Without pupil dilation:
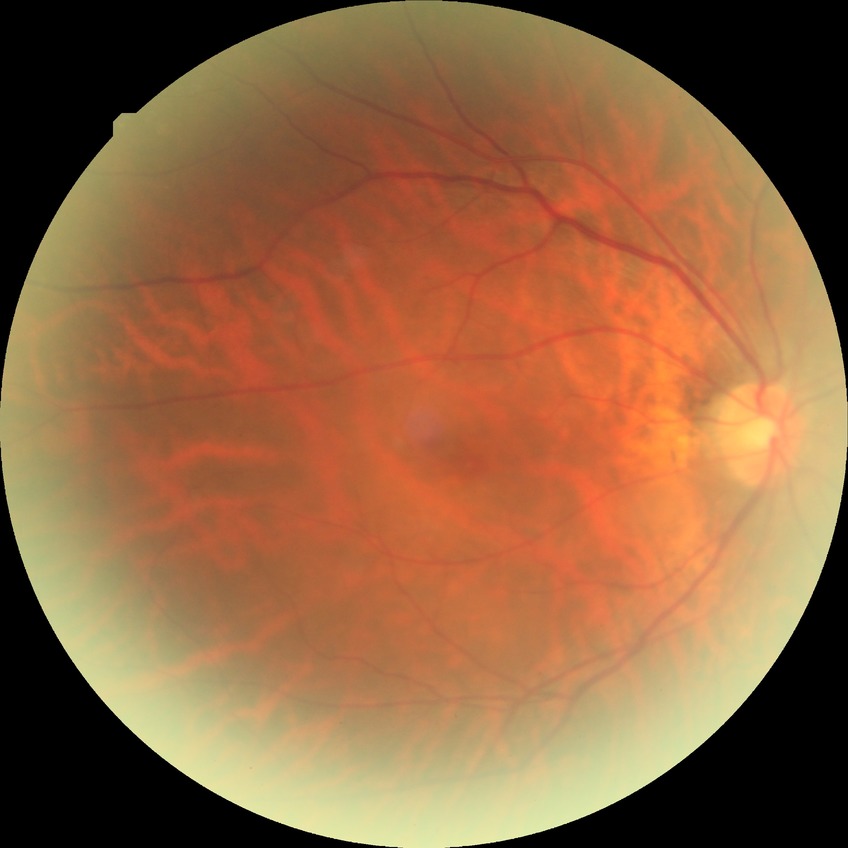   davis_grade: NDR (no diabetic retinopathy)